DR severity per modified Davis staging — 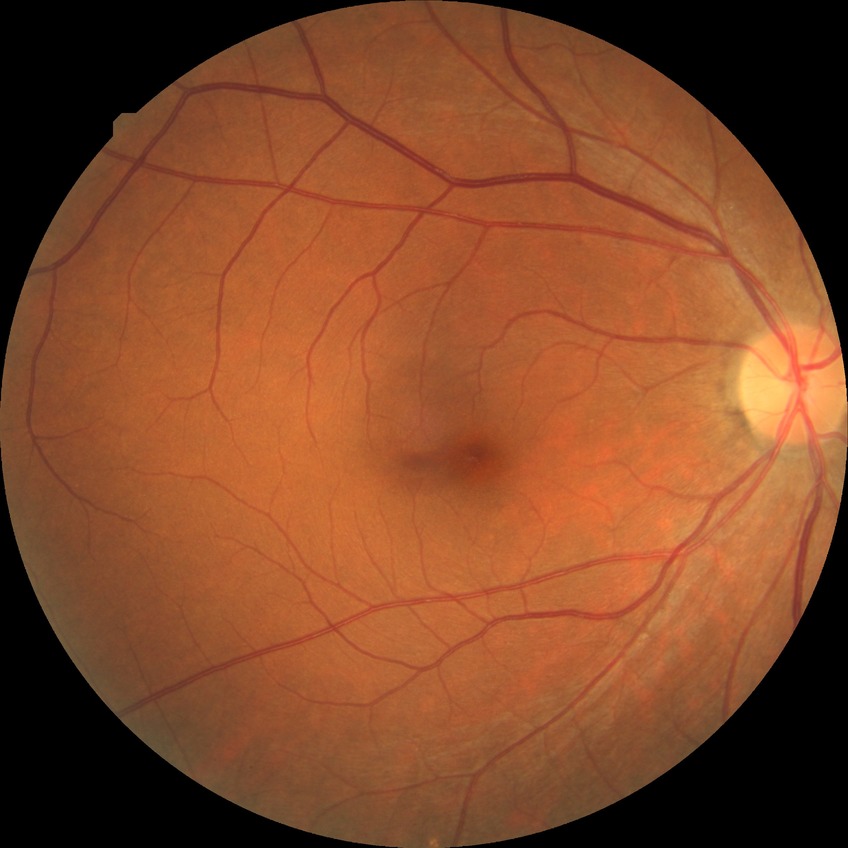 Modified Davis classification is no diabetic retinopathy.